Graded on the modified Davis scale, no pharmacologic dilation — 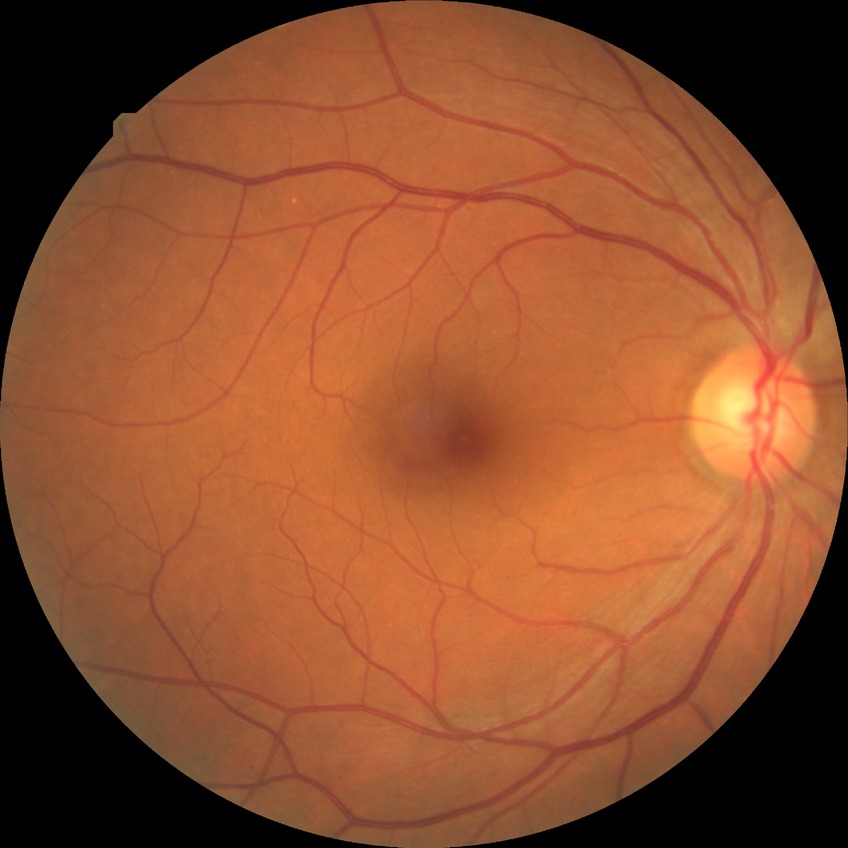
Modified Davis grading is no diabetic retinopathy.